1240x1240px; wide-field fundus photograph from neonatal ROP screening; captured with the Phoenix ICON (100° field of view) — 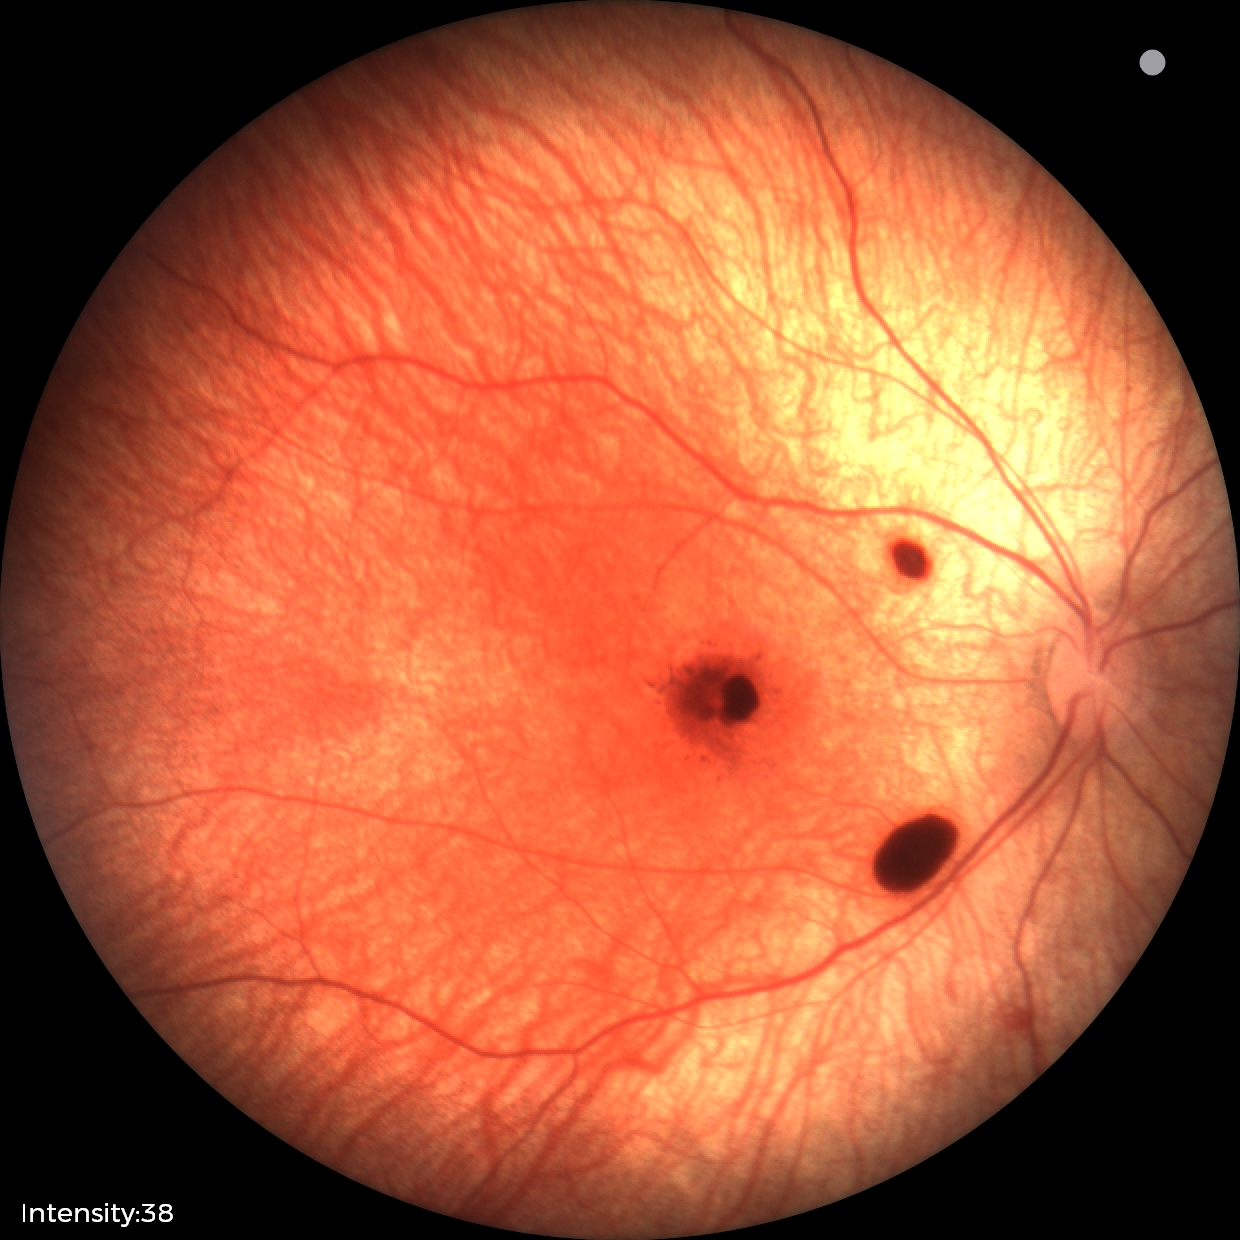 Assessment: retinal hemorrhages.